CFP:
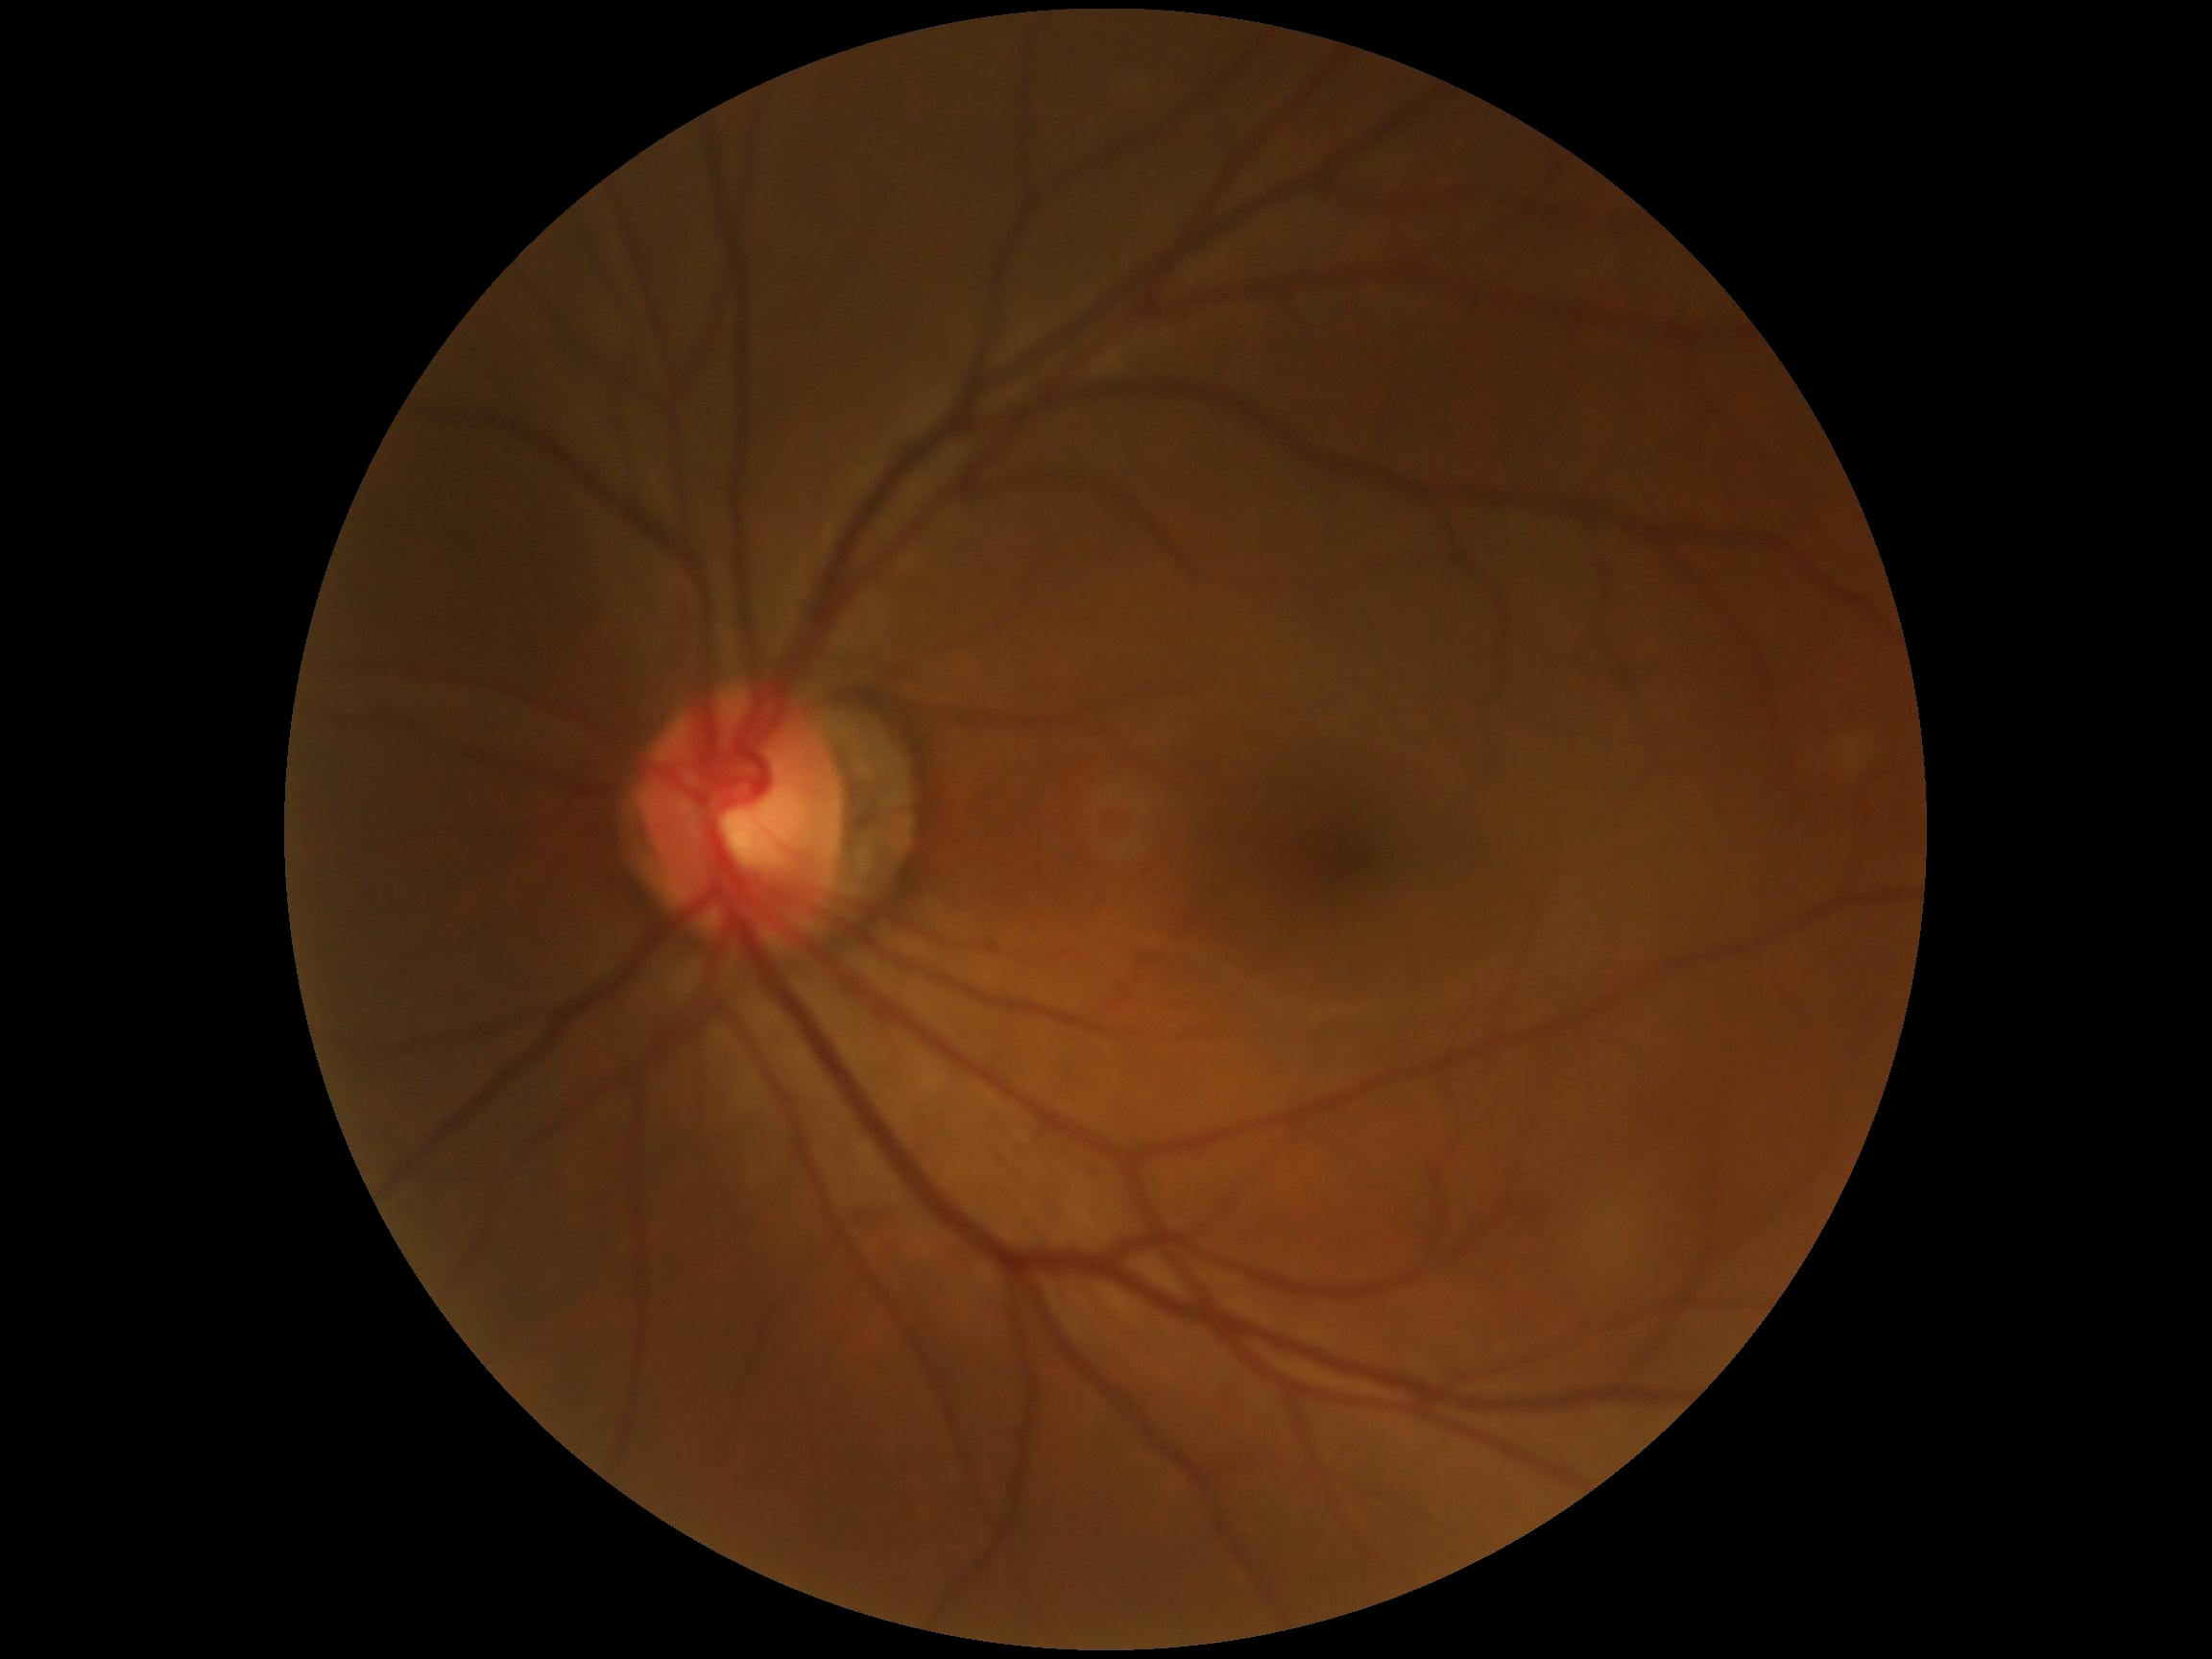 No signs of diabetic retinopathy.
DR: grade 0.